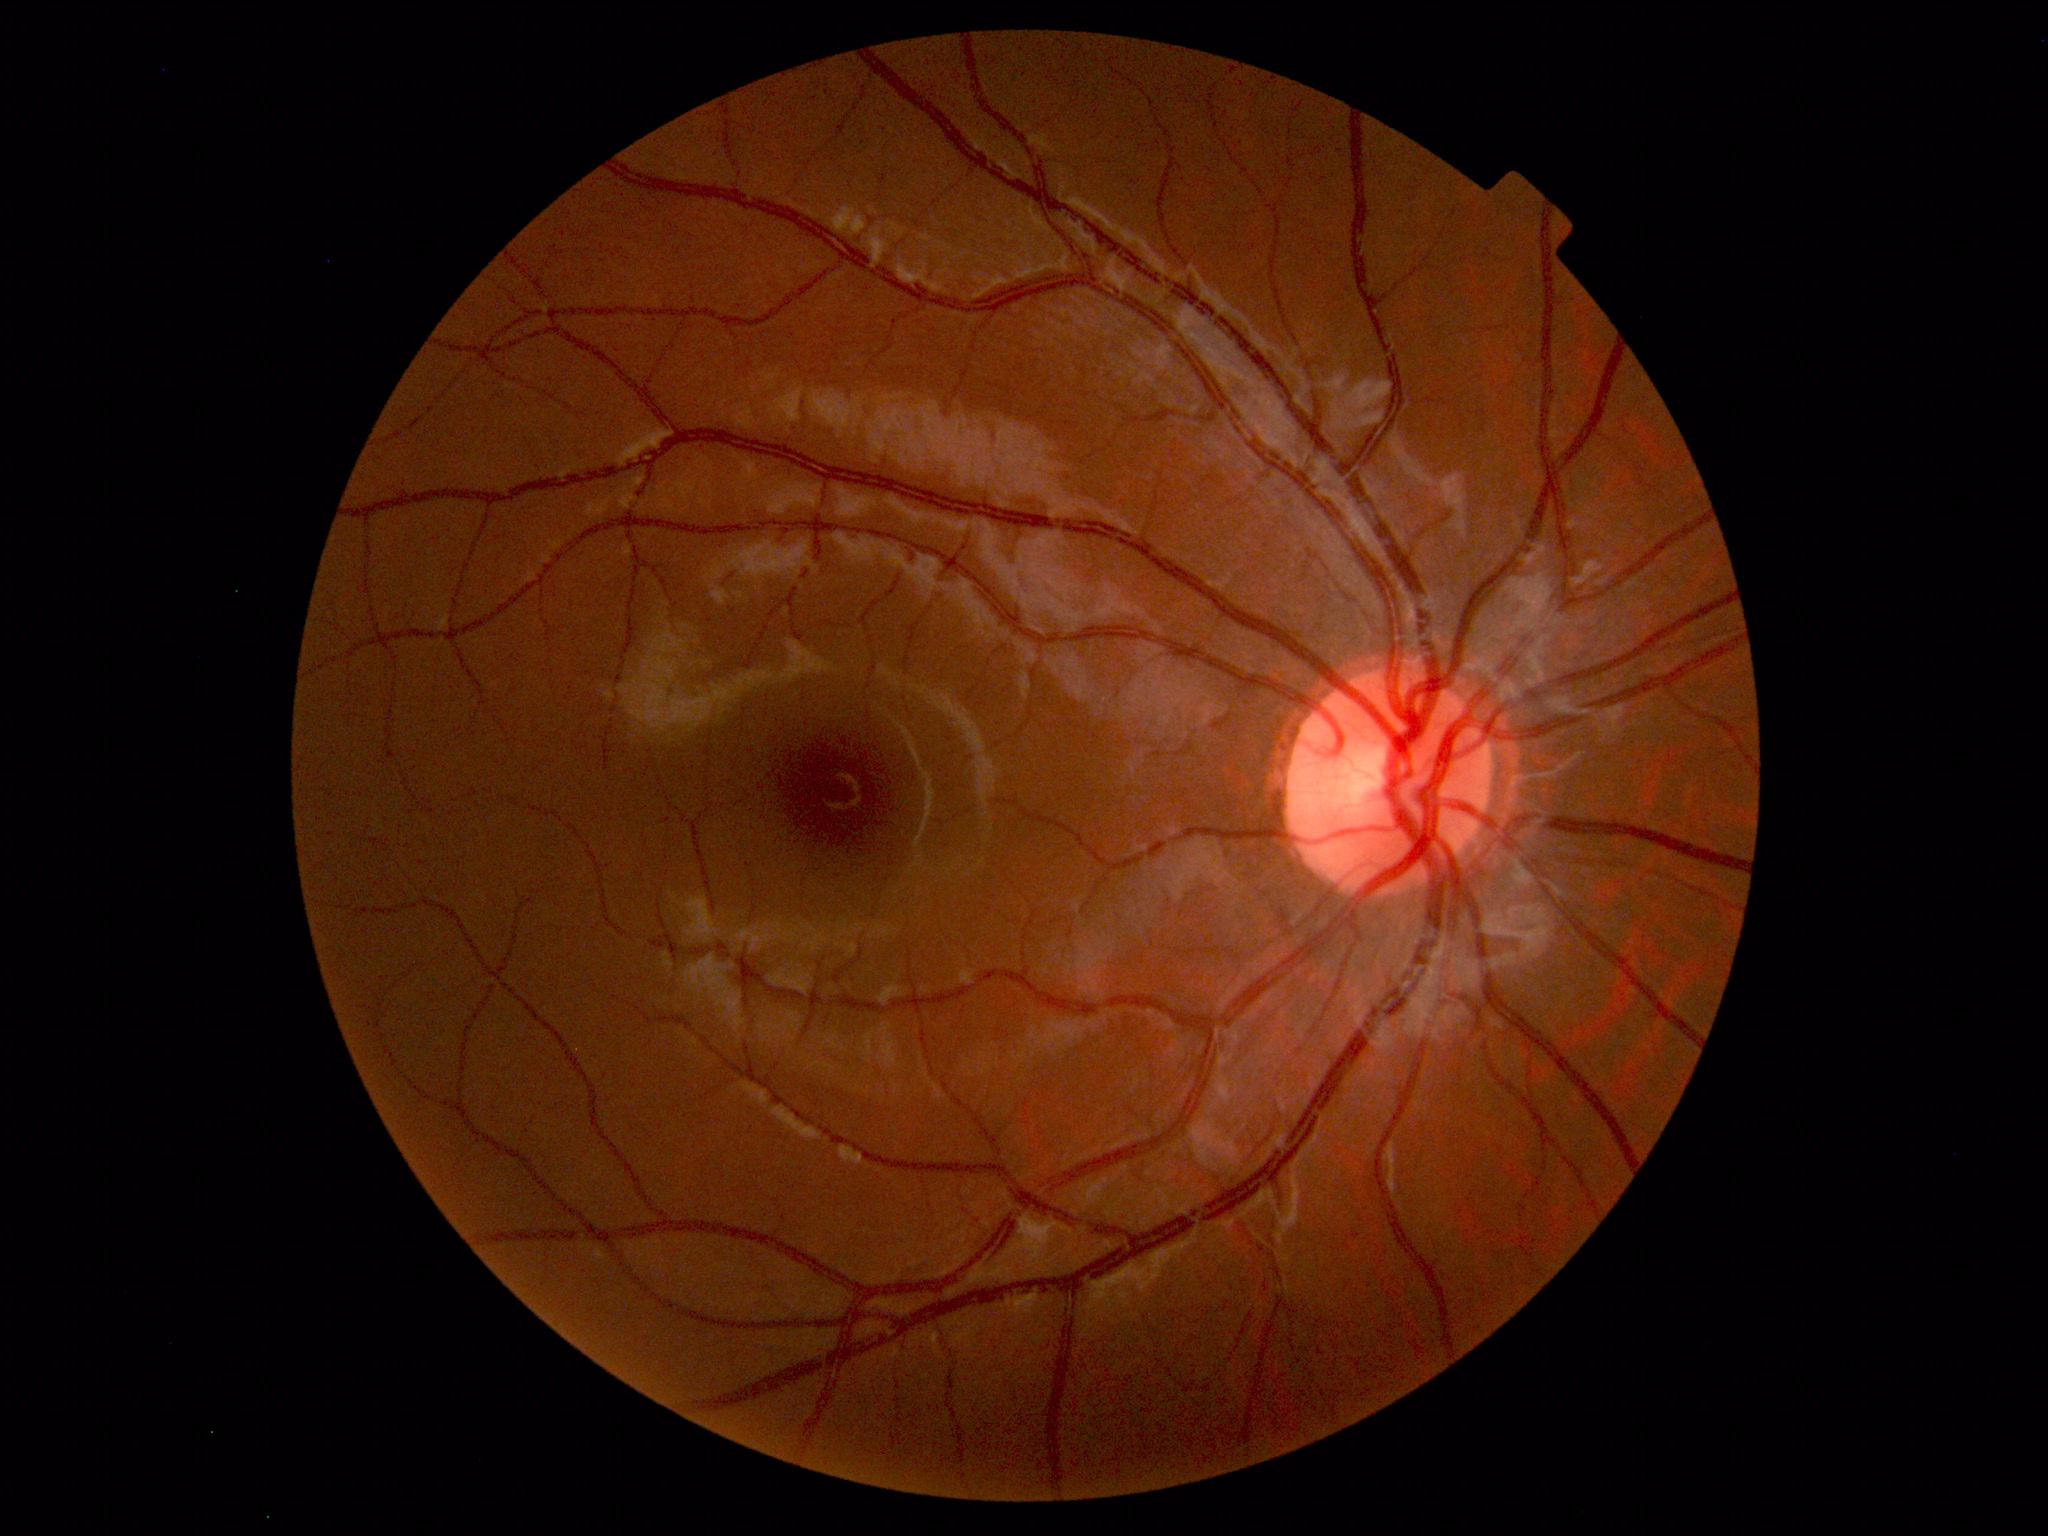 The fundus appears normal with no pathological findings.